240 x 240 pixels; cropped to the optic nerve head — 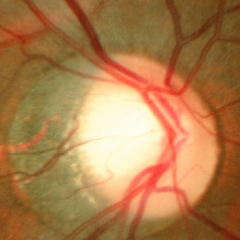 The image shows early-stage glaucoma.